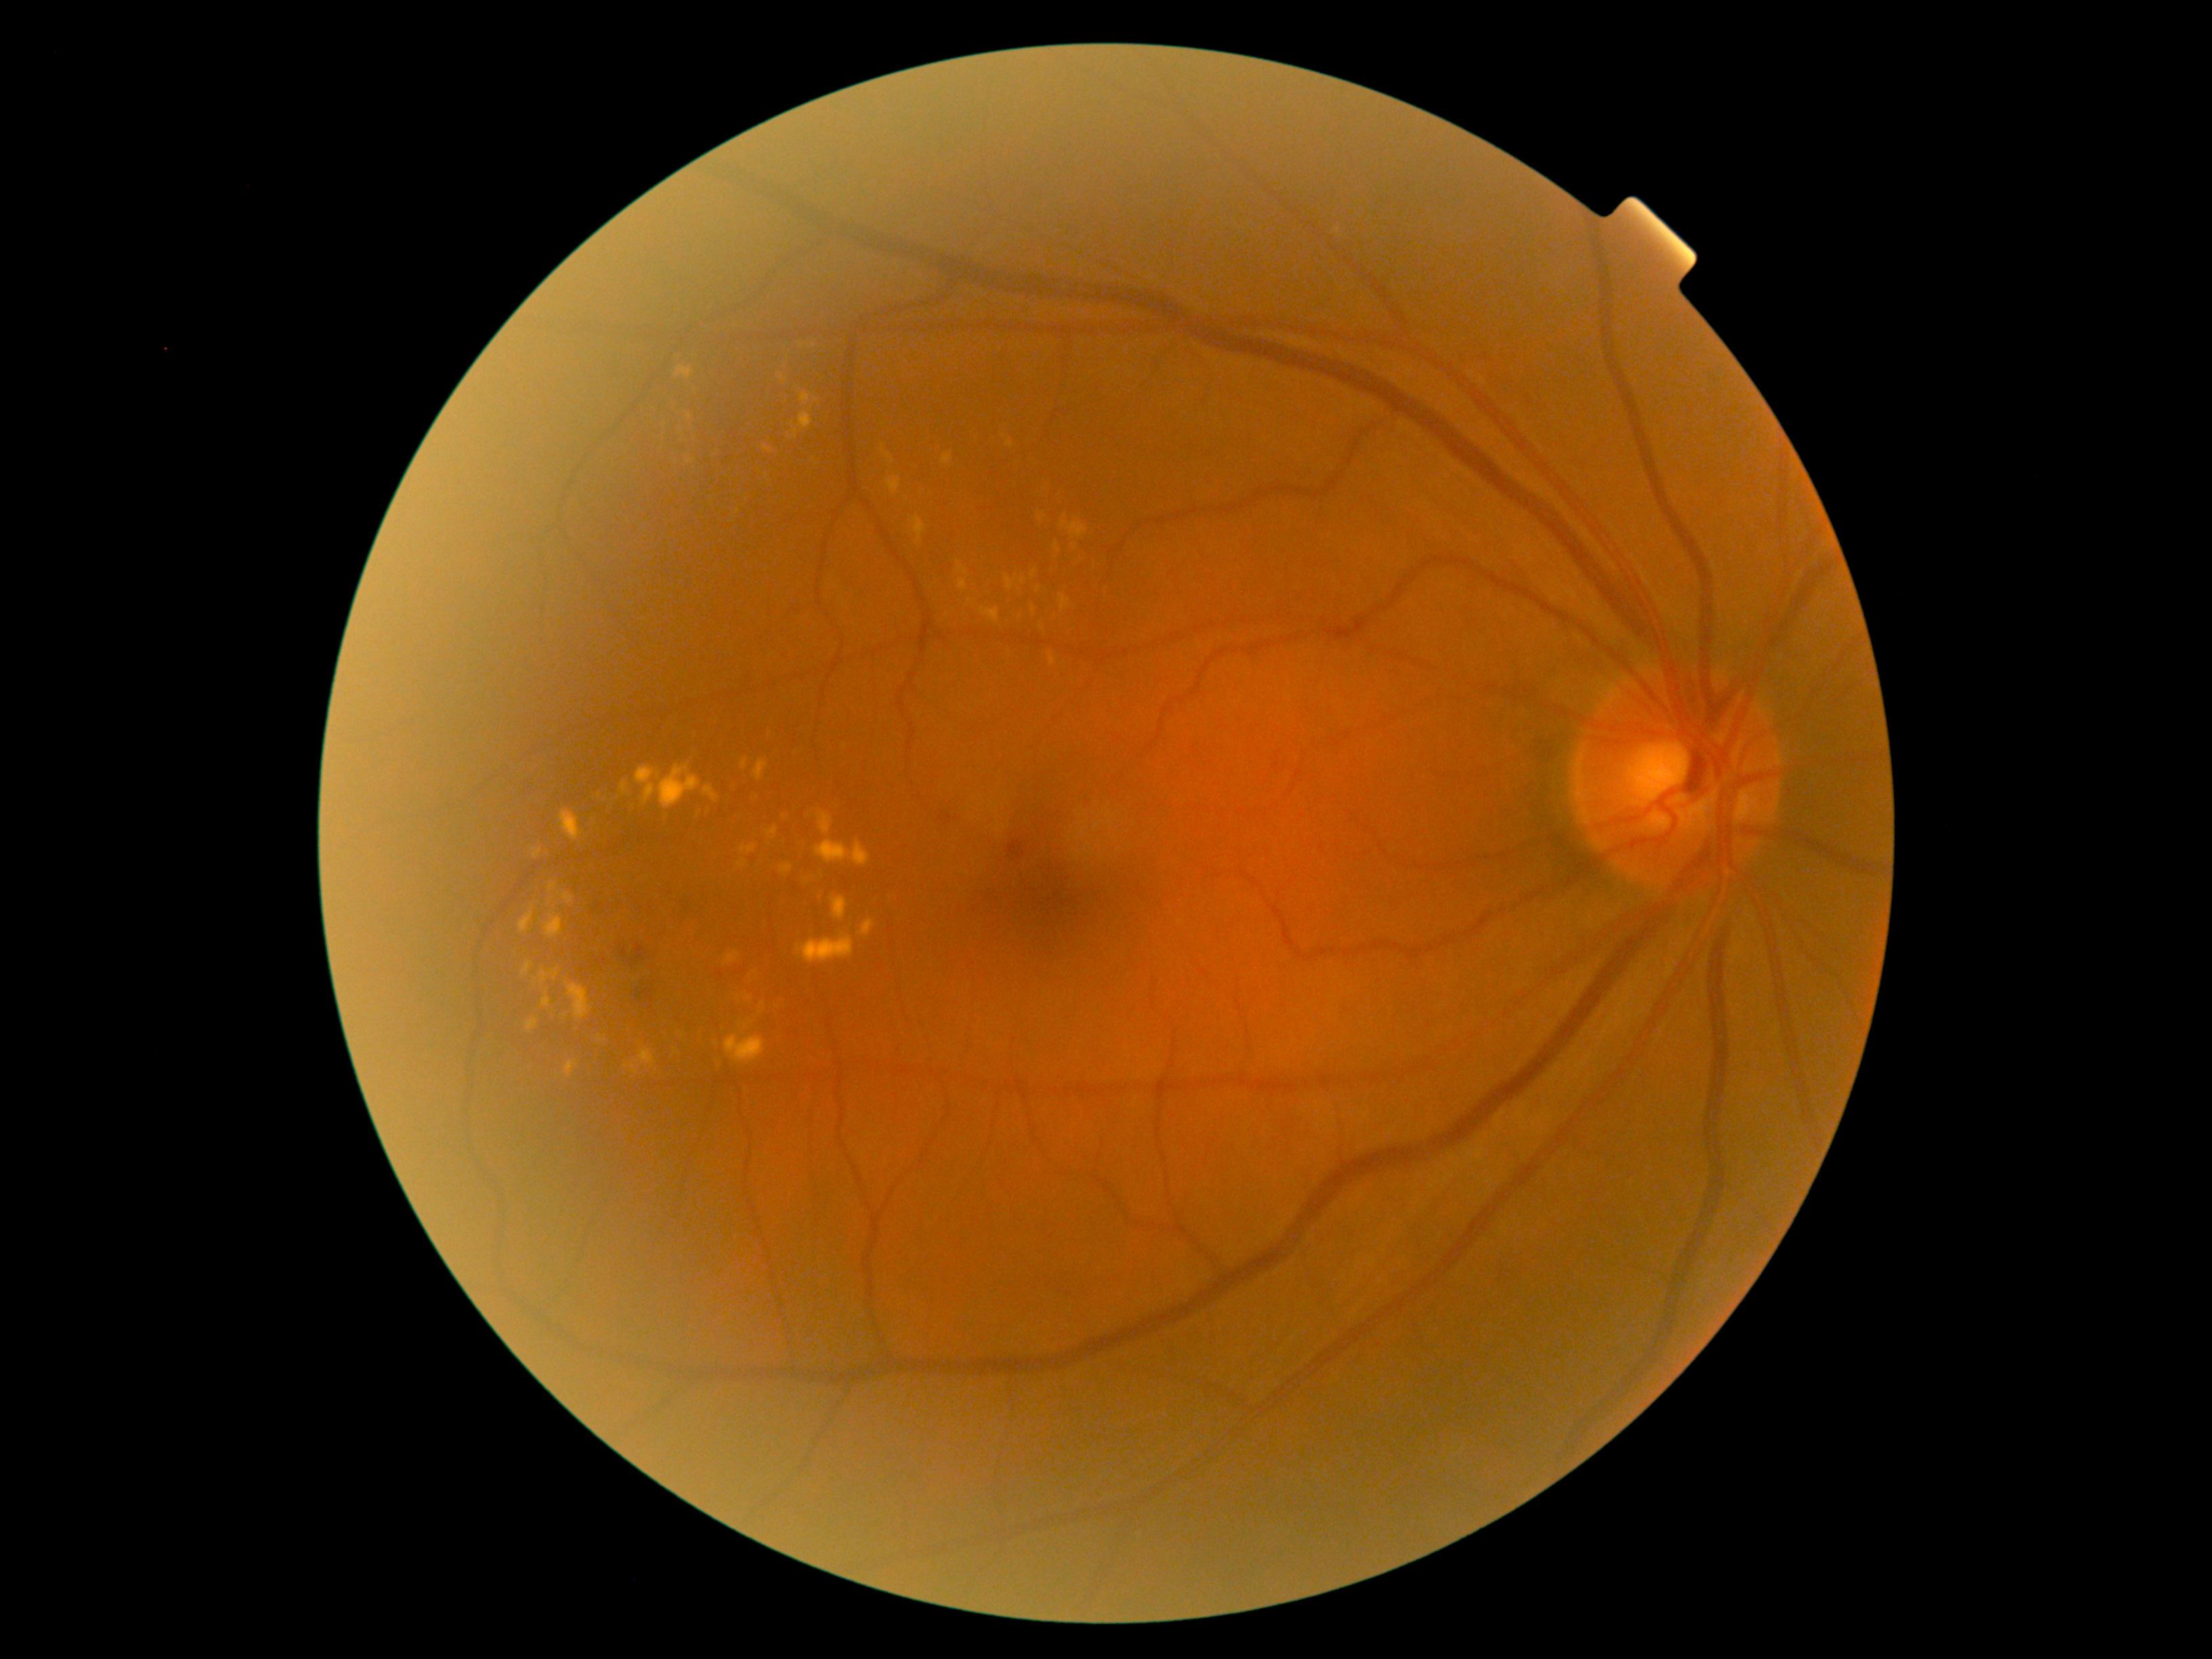
Diabetic retinopathy (DR) is grade 2 (moderate NPDR). Hard exudates (EXs) include those at (738, 860, 747, 867), (832, 897, 846, 920), (745, 997, 754, 1002), (860, 920, 875, 937), (799, 413, 813, 429), (551, 968, 558, 981), (544, 916, 563, 940), (780, 864, 792, 875), (765, 827, 779, 838), (543, 996, 551, 1008), (958, 579, 967, 592), (815, 840, 869, 865), (754, 760, 768, 781), (726, 952, 741, 964). Small EXs near x=969 y=603, x=815 y=346, x=738 y=512, x=1040 y=519, x=566 y=1016, x=689 y=417.